240x240; non-mydriatic fundus camera
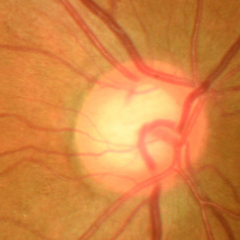
Glaucoma status = no evidence of glaucoma.